Color fundus photograph: 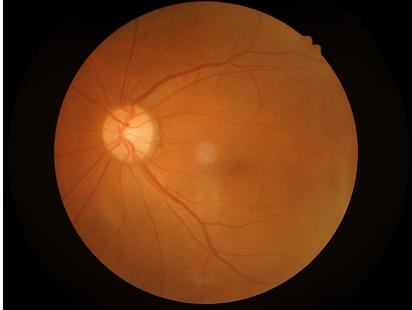

  overall_quality: good, gradable
  illumination: no over- or under-exposure
  contrast: wide intensity range, structures distinguishable